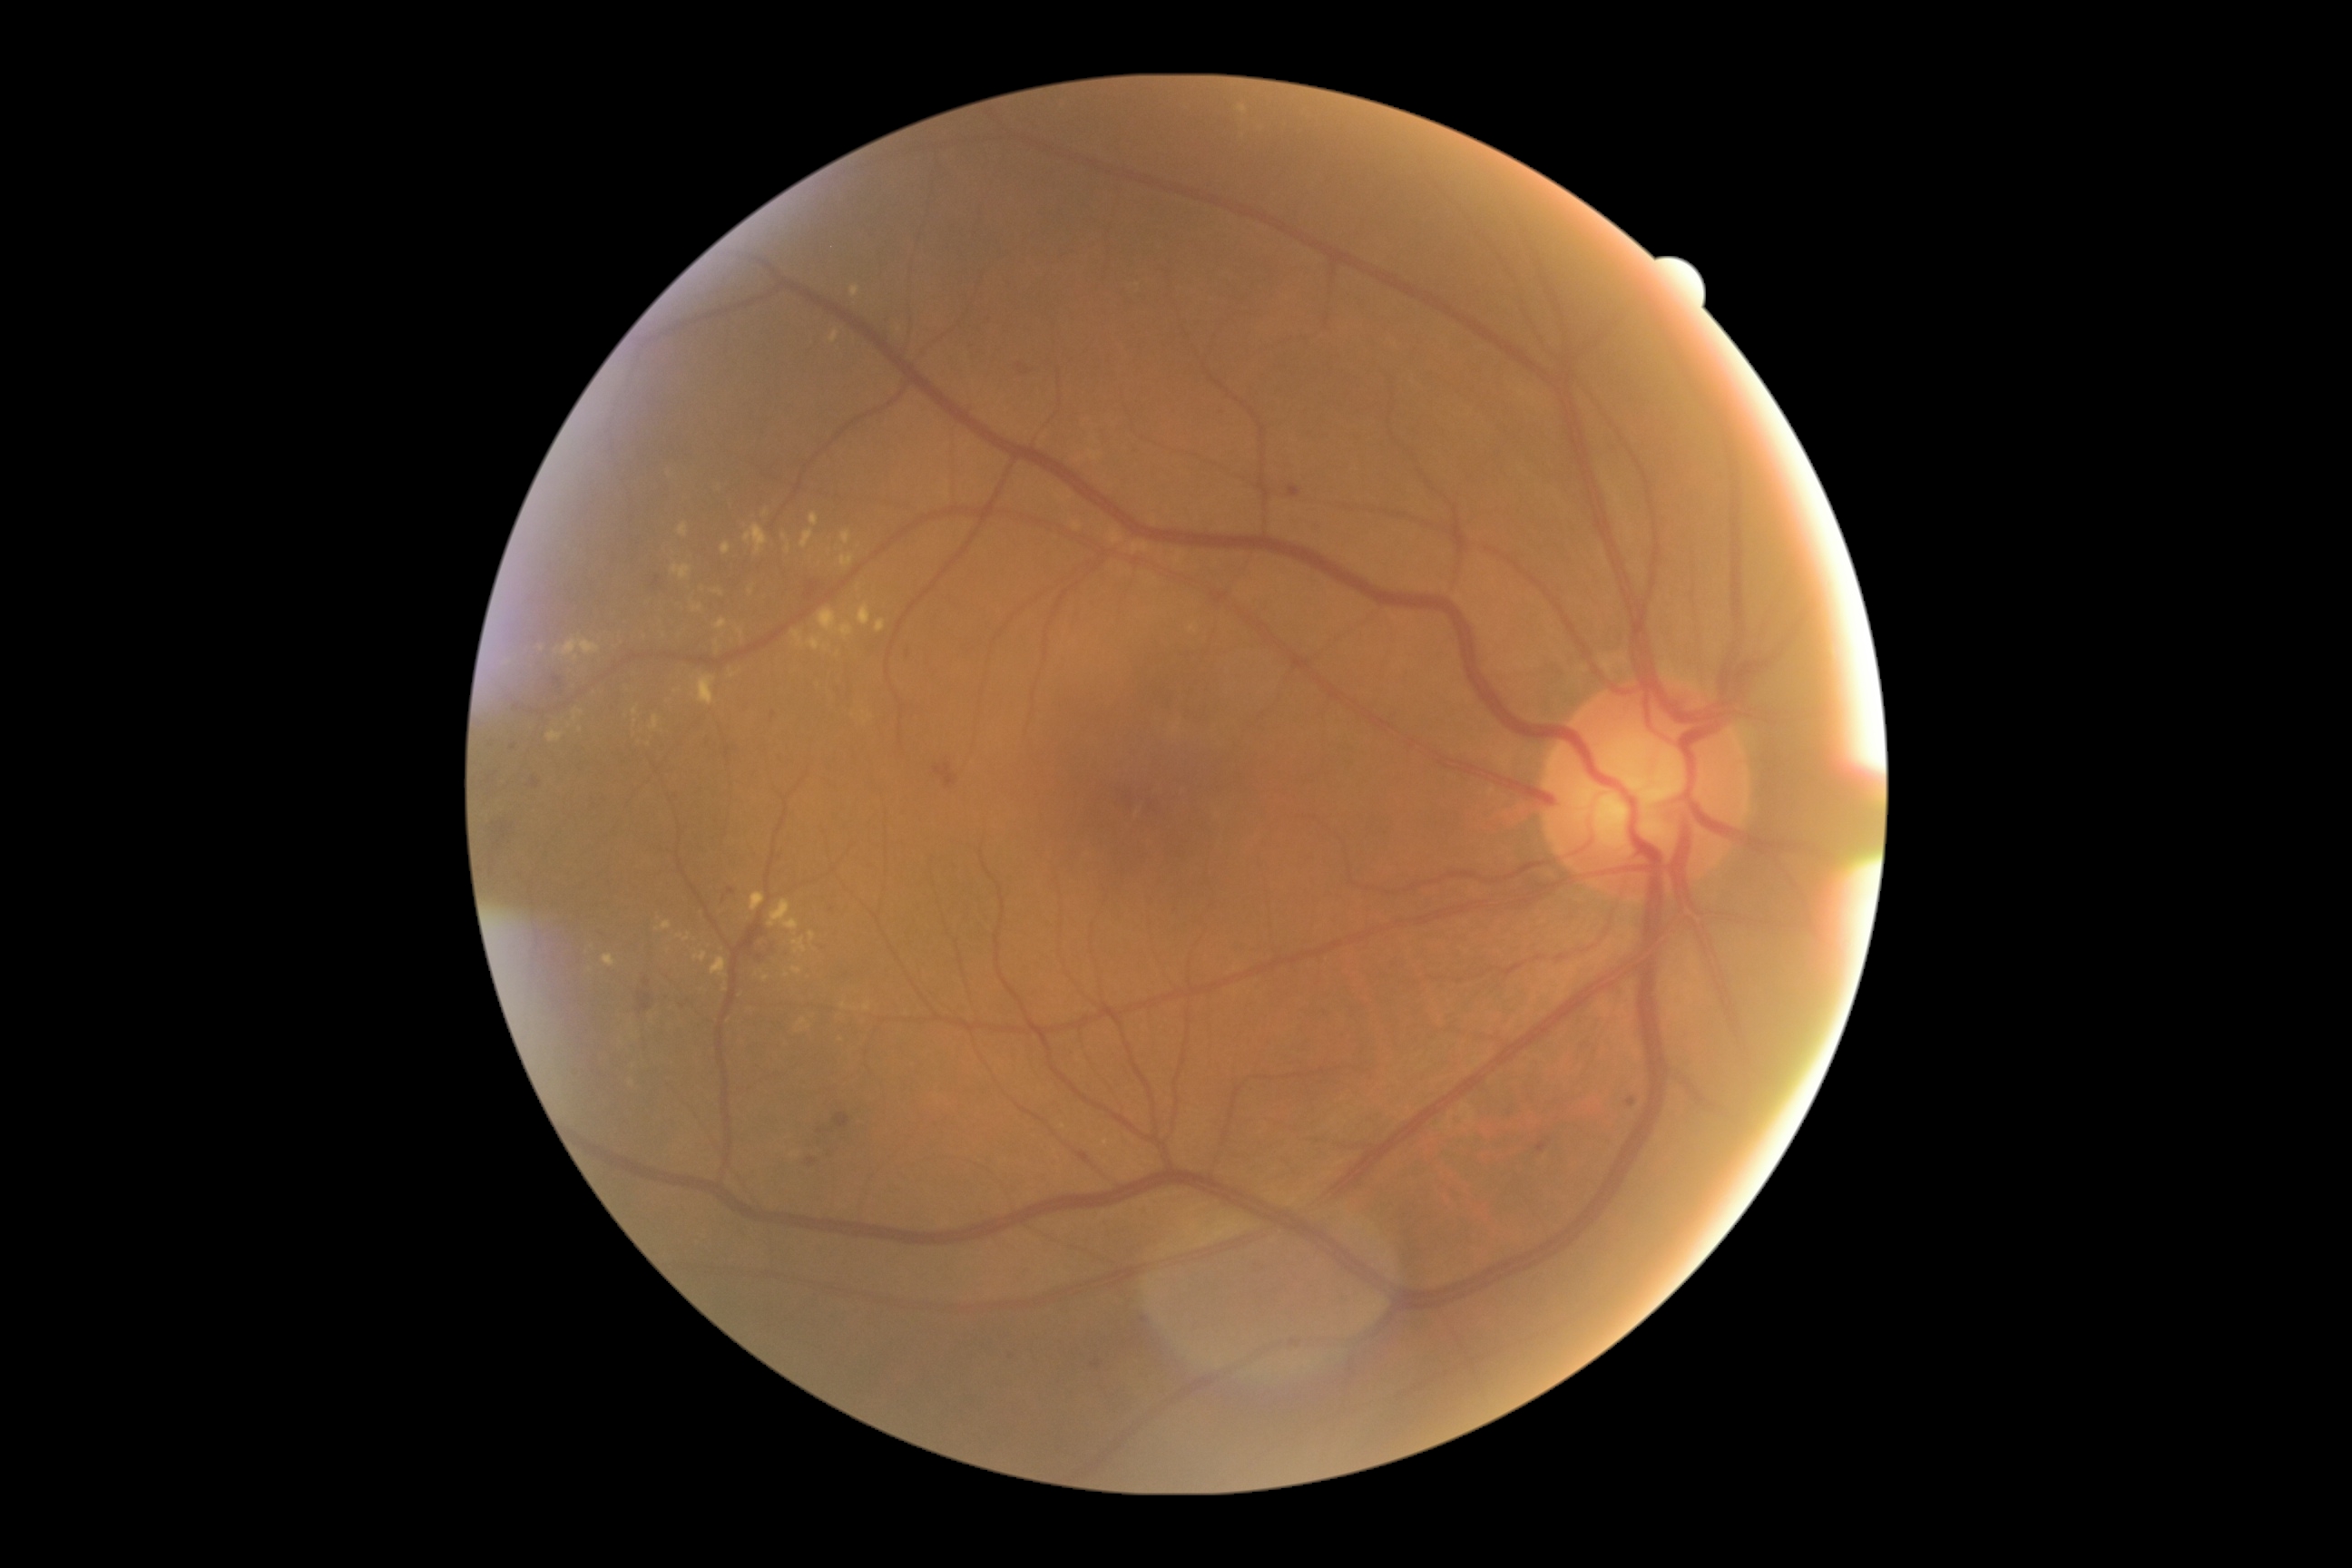
{"partial": true, "dr_grade": 2, "lesions": {"ex": [[698, 676, 716, 705], [658, 921, 672, 932], [810, 932, 816, 941], [547, 730, 564, 743], [858, 605, 870, 627], [651, 716, 660, 730], [801, 531, 814, 549], [841, 531, 852, 545], [761, 975, 769, 983], [749, 585, 754, 596], [574, 710, 582, 721], [865, 1004, 870, 1012], [745, 525, 769, 554]], "ex_small_centers": [[785, 537], [718, 643], [543, 649], [844, 1007]]}}